Wide-field fundus photograph of an infant — 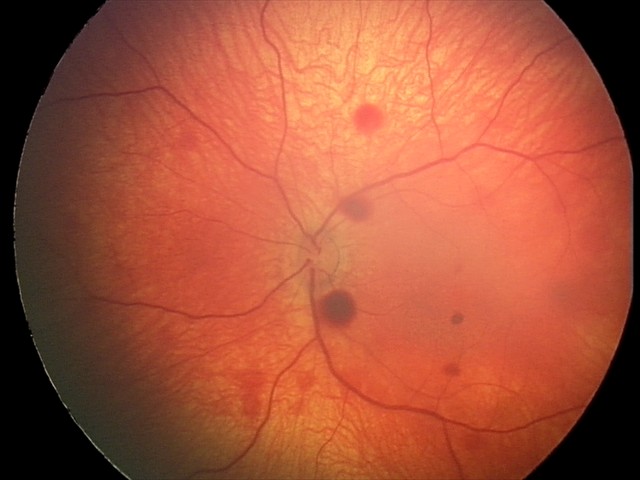
From an examination with diagnosis of retinal hemorrhages.